45° FOV — 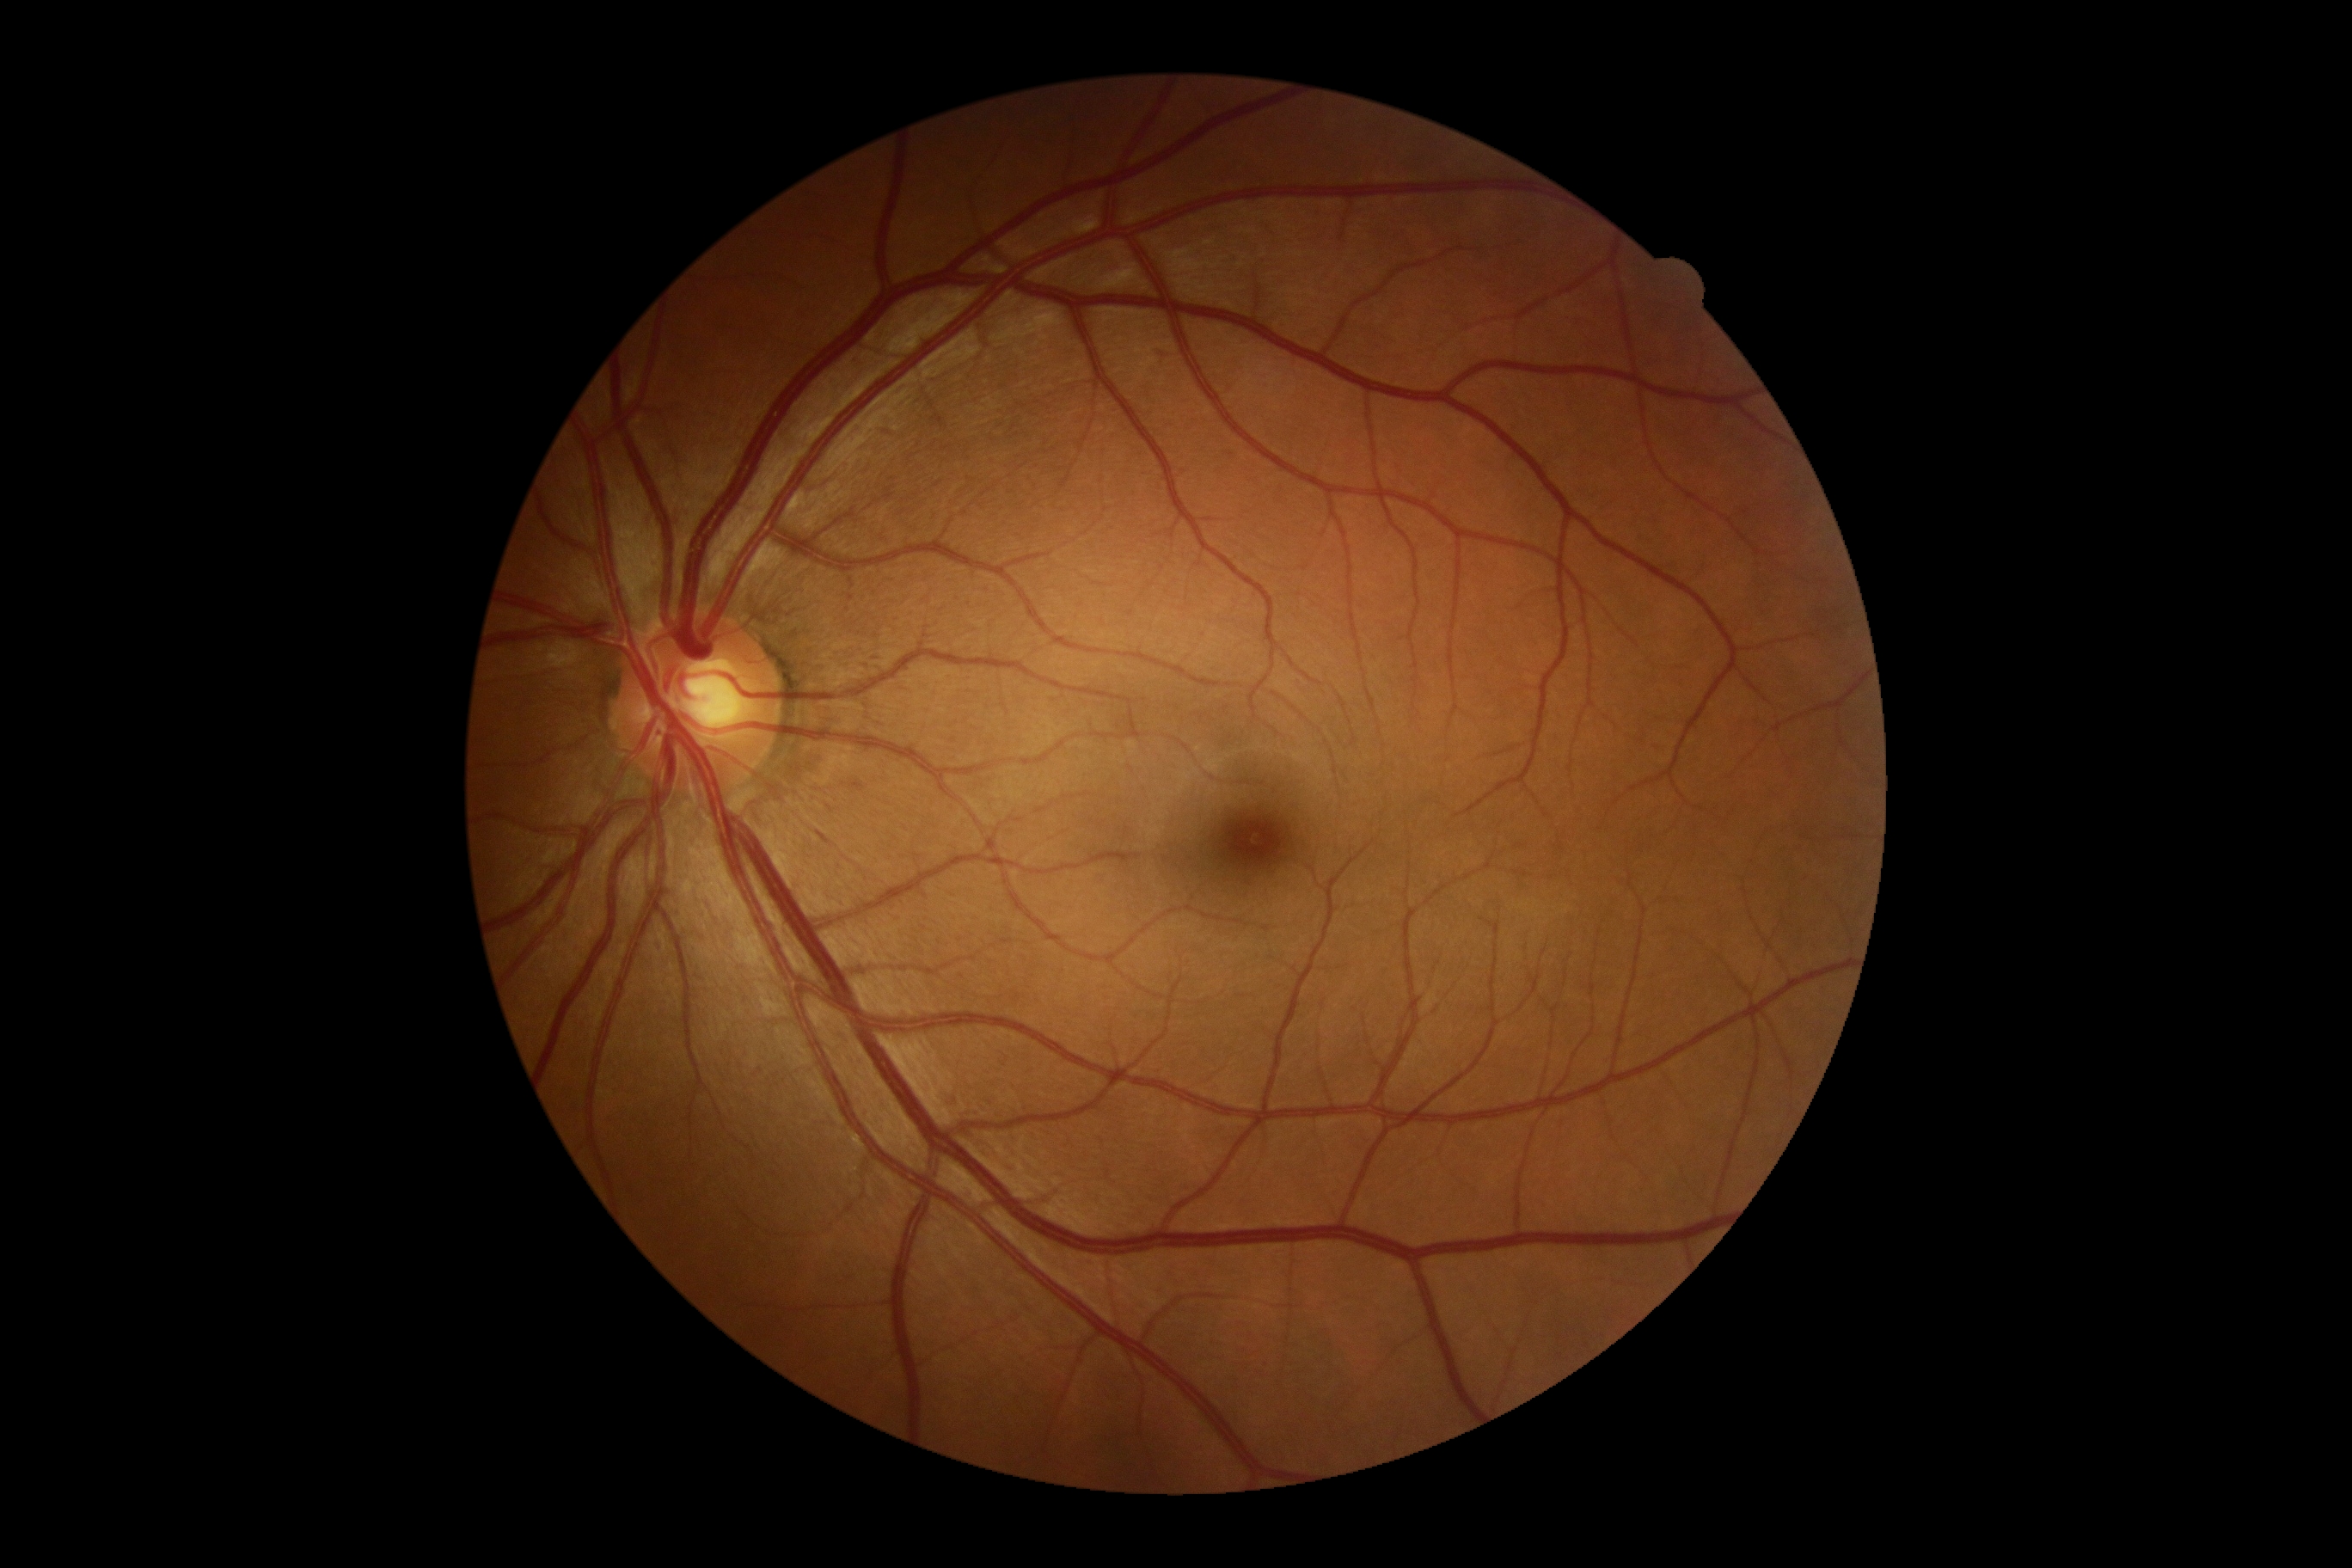 Diabetic retinopathy (DR) is grade 0 (no apparent retinopathy). No signs of diabetic retinopathy.